Color fundus photograph
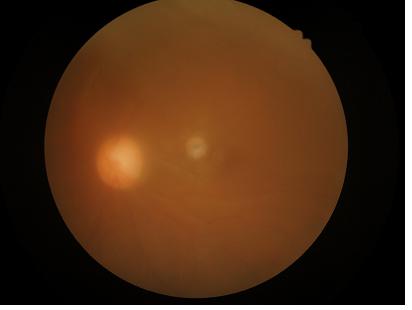 Contrast is low. Overall quality is poor; the image is difficult to grade. There is over- or under-exposure or a color cast. Noticeable blur in the optic disc, vessels, or background.